CFP:
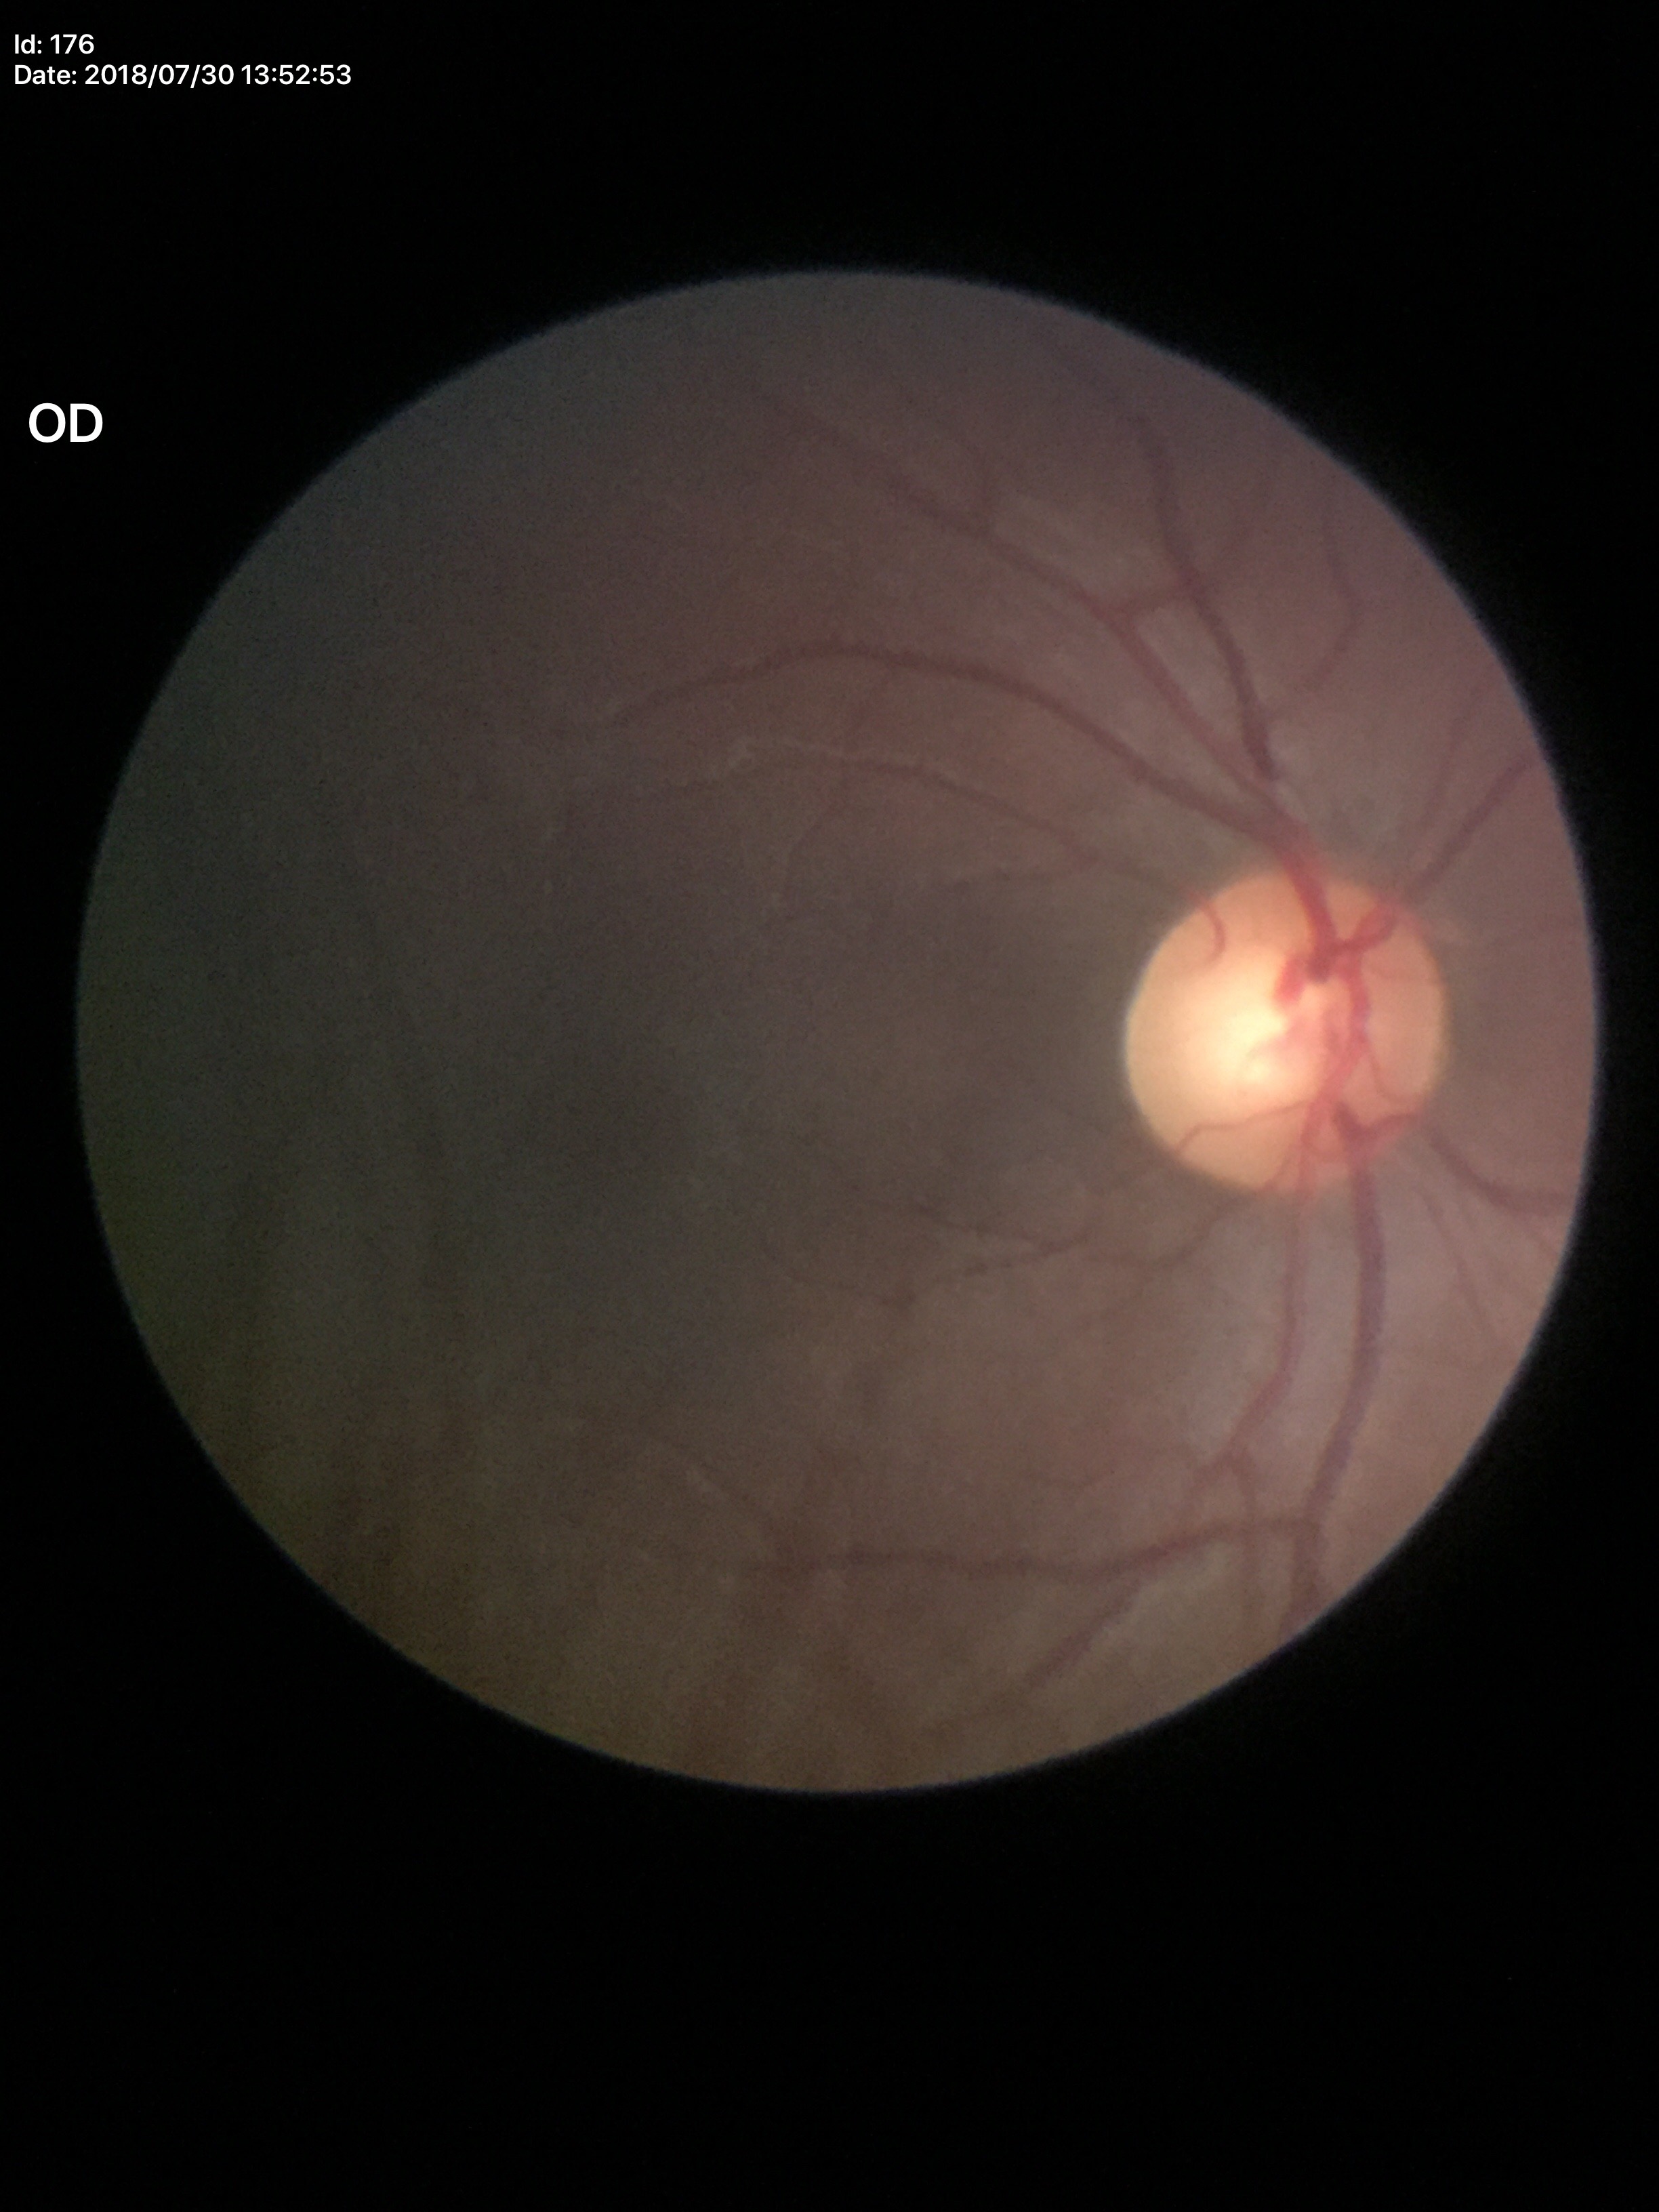

Horizontal C/D ratio of 0.61.
Negative for glaucoma suspicion.
Vertical cup-to-disc ratio is 0.59.